NIDEK AFC-230, nonmydriatic fundus photograph.
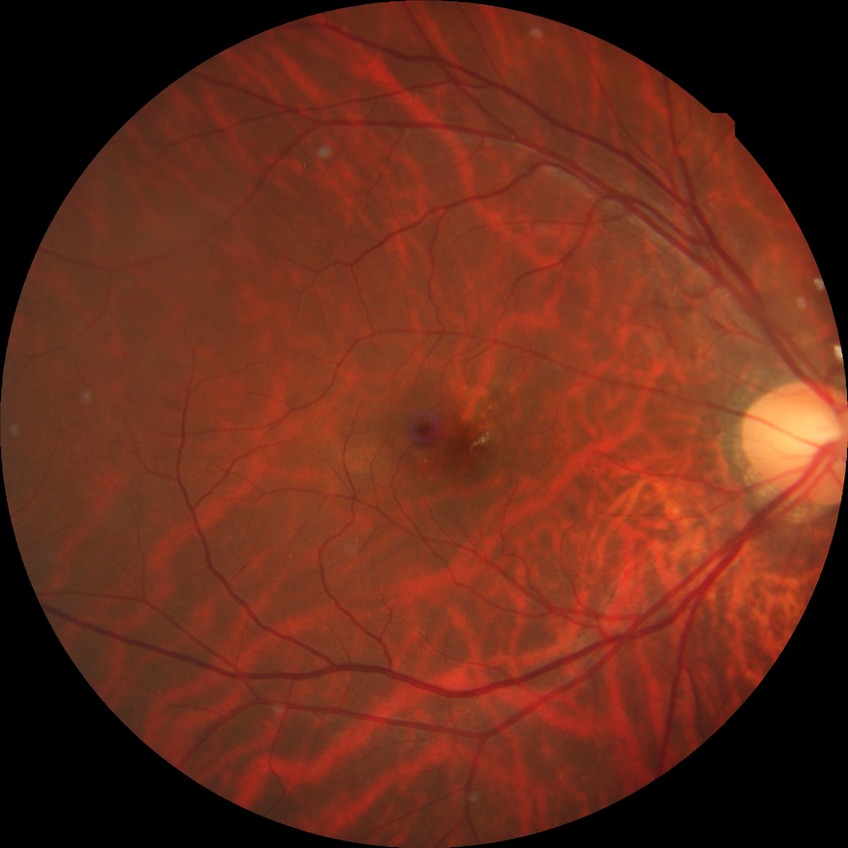
  davis_grade: no diabetic retinopathy (NDR)